Retinal fundus photograph; NIDEK AFC-230; 45° FOV; nonmydriatic fundus photograph; 848 x 848 pixels: 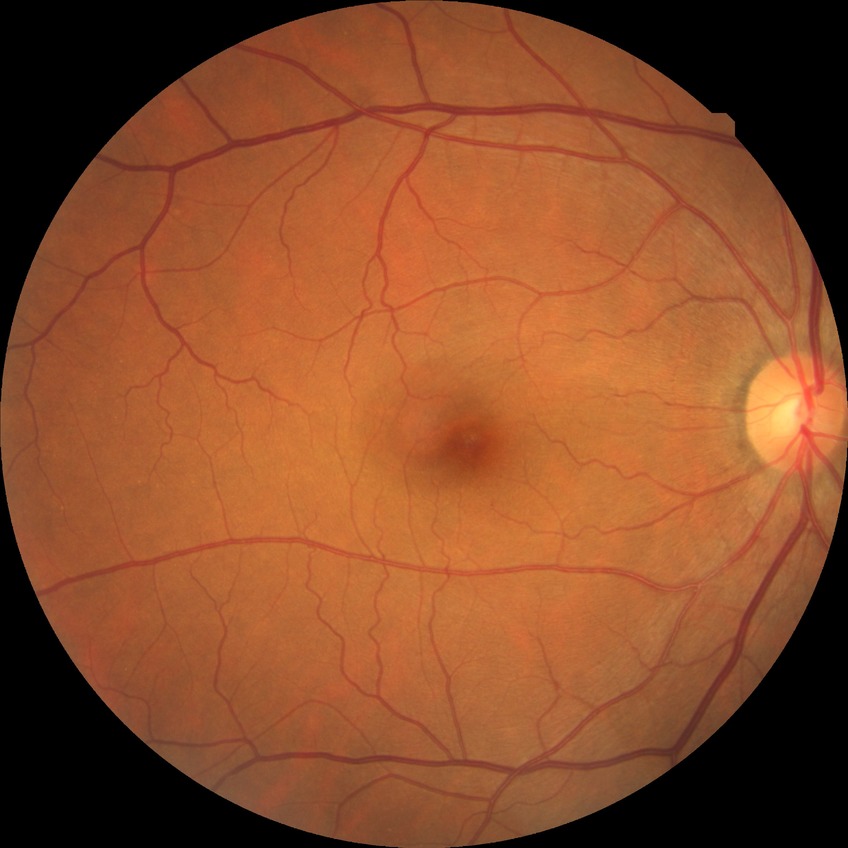
- diabetic retinopathy (DR): NDR (no diabetic retinopathy)